Fundus photo.
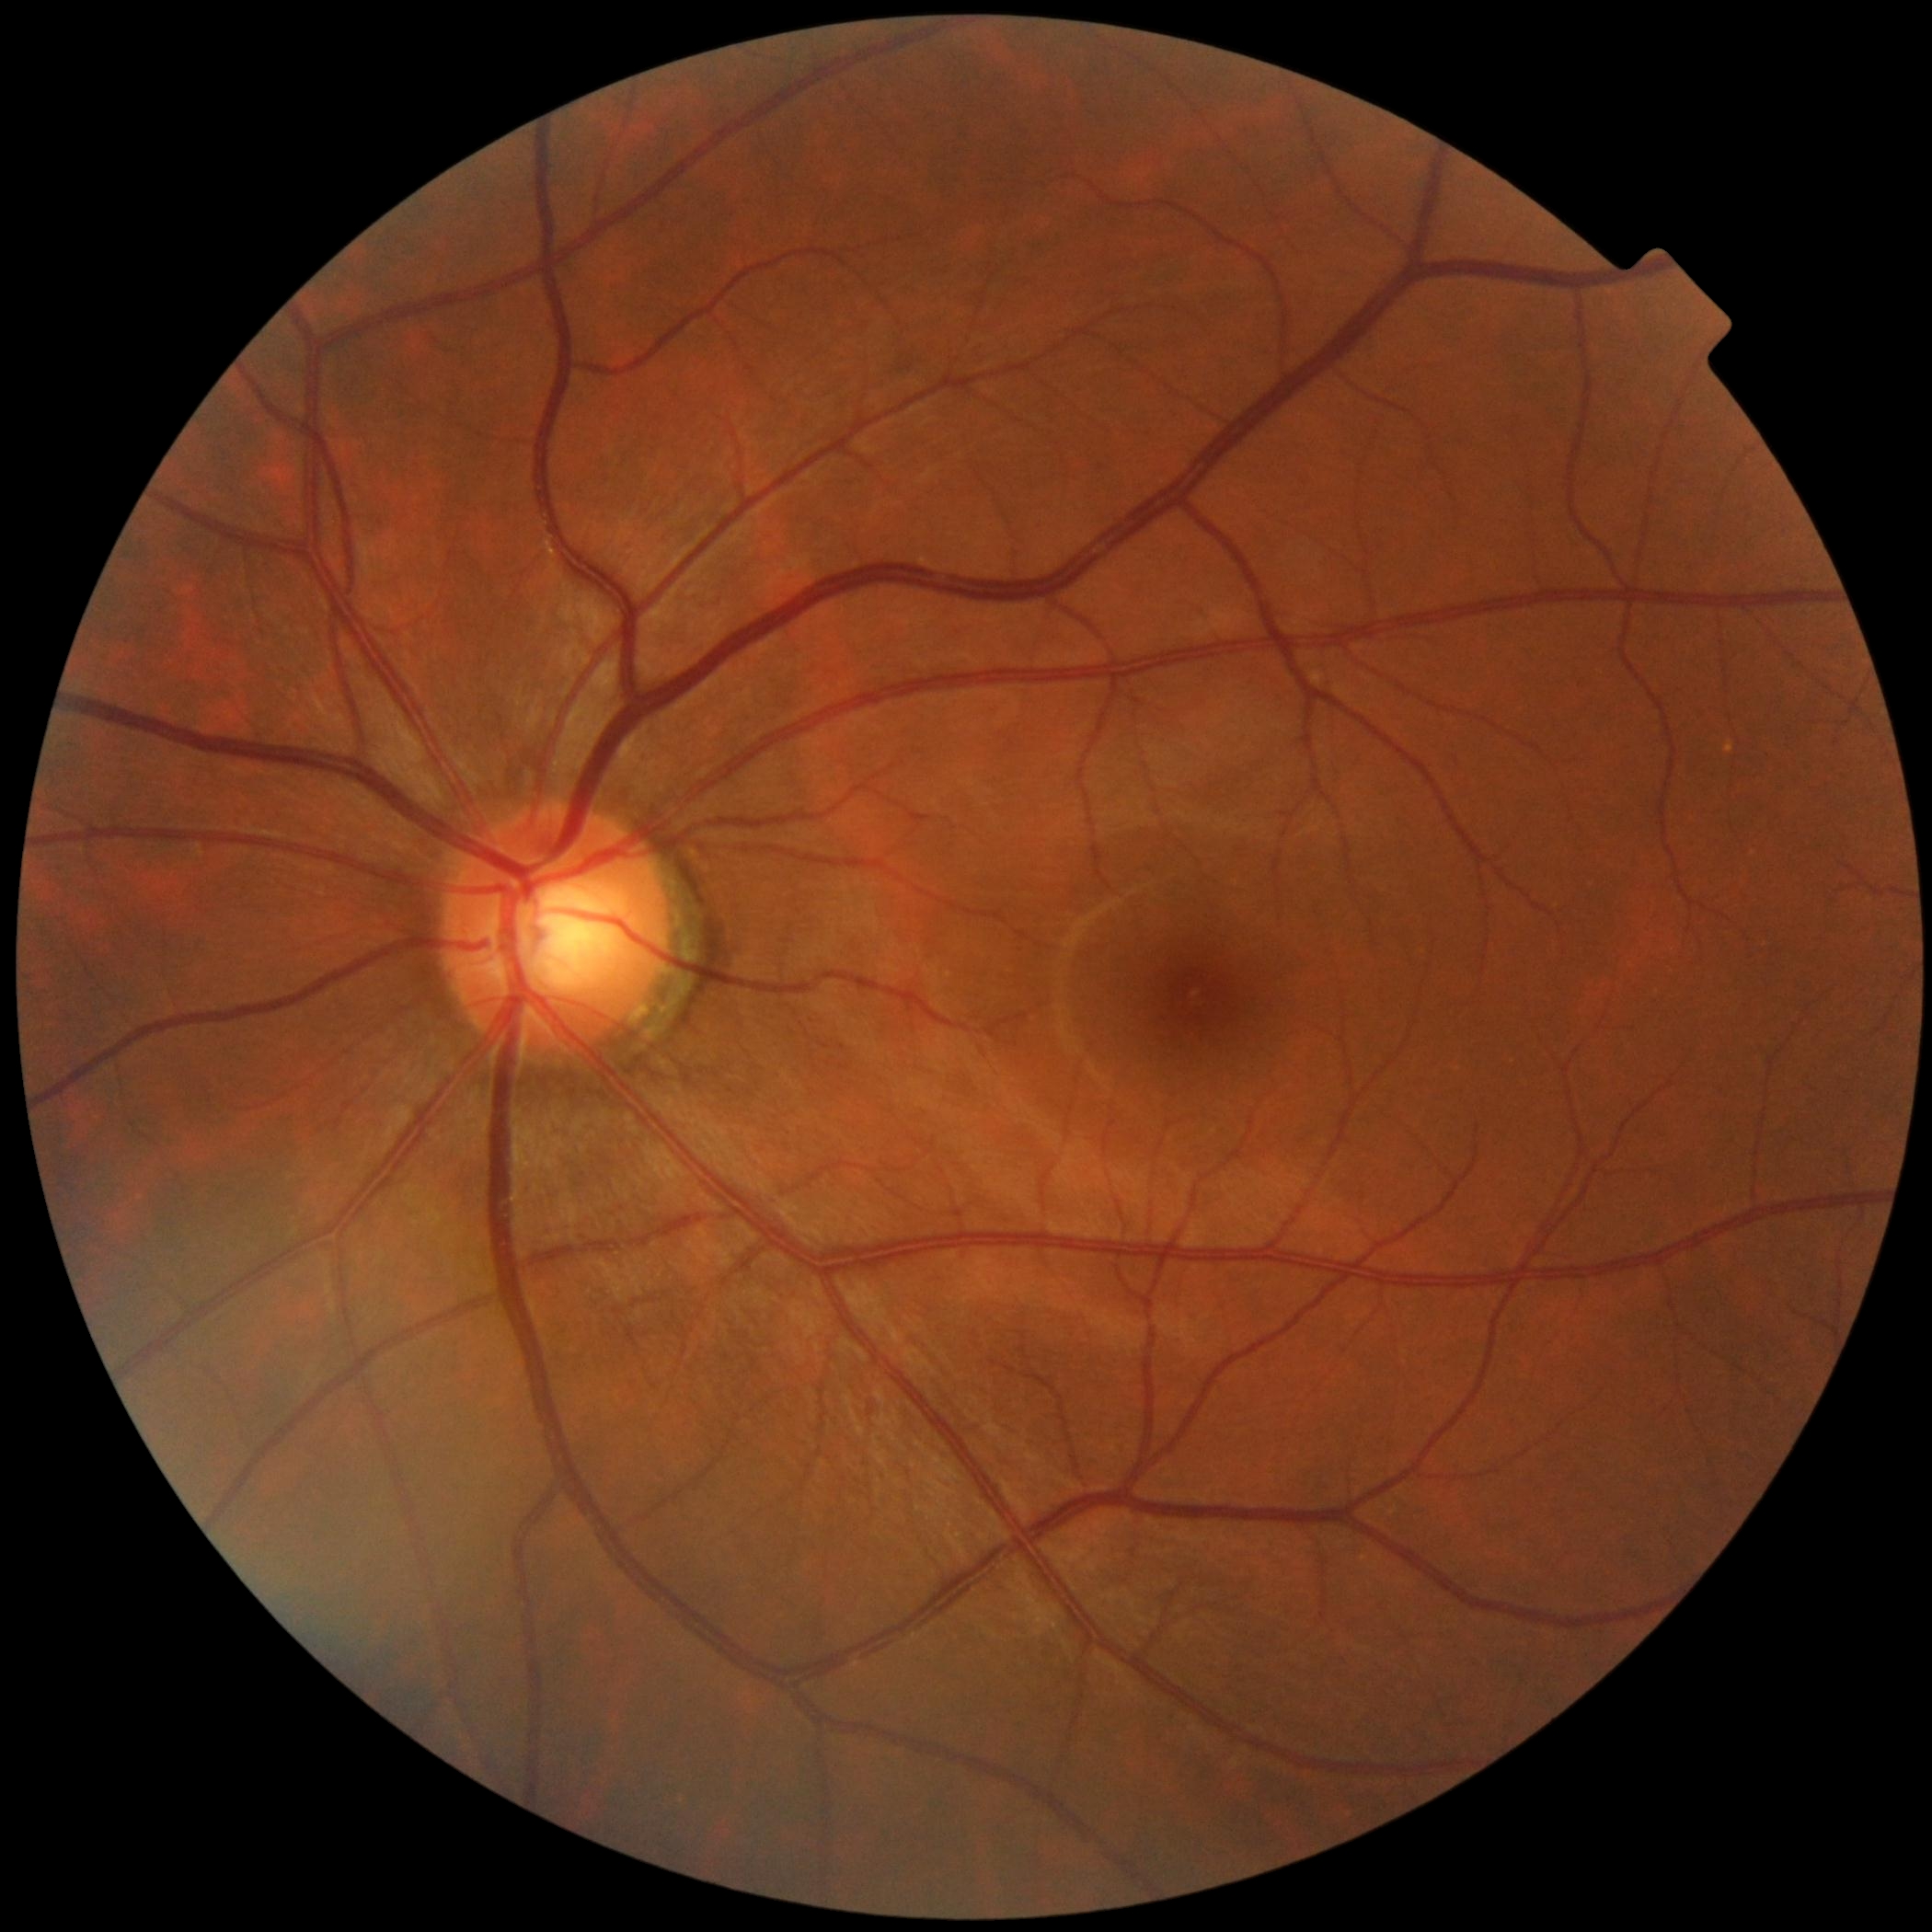
  dr_impression: no DR findings
  dr_grade: grade 0 (no apparent retinopathy)